Wide-field contact fundus photograph of an infant. Clarity RetCam 3, 130° FOV: 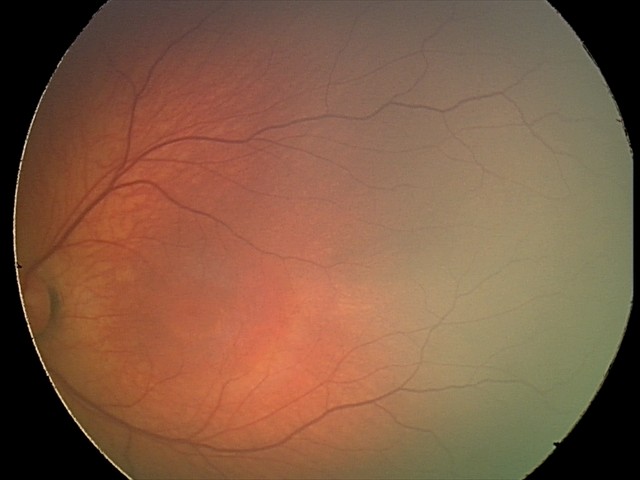 Assessment: no abnormal retinal findings.